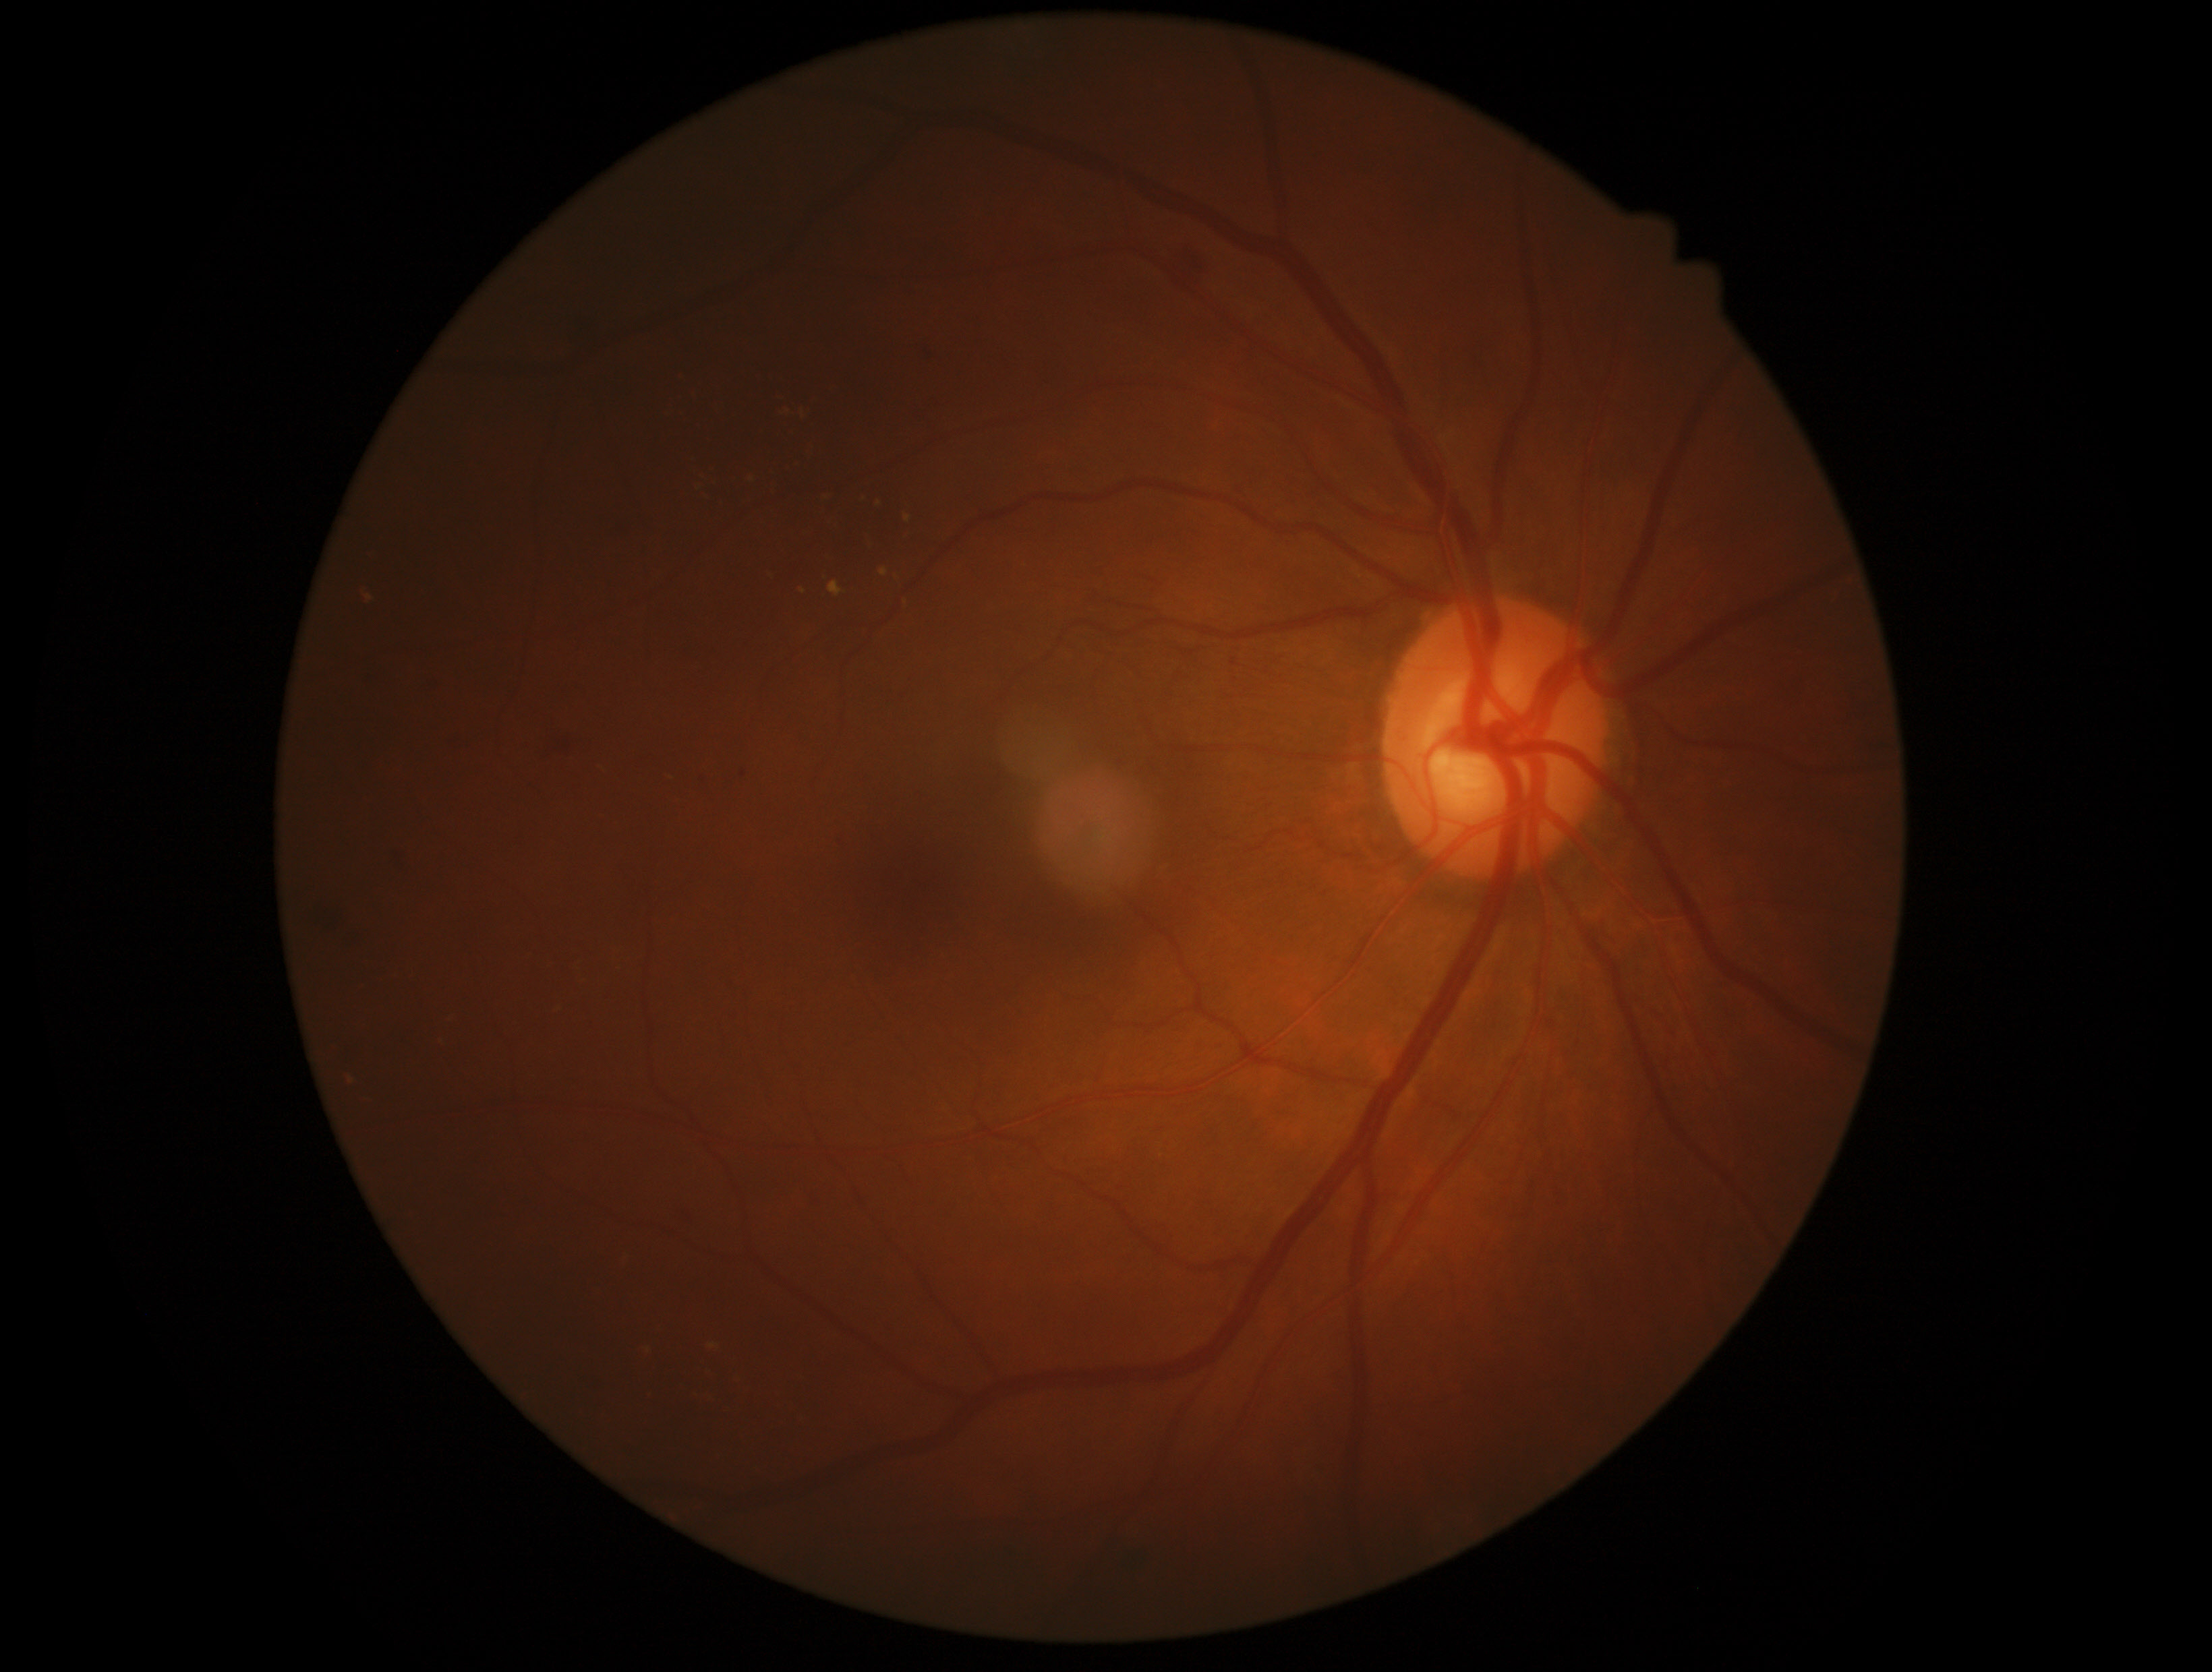

Diabetic retinopathy (DR) is moderate NPDR (grade 2).